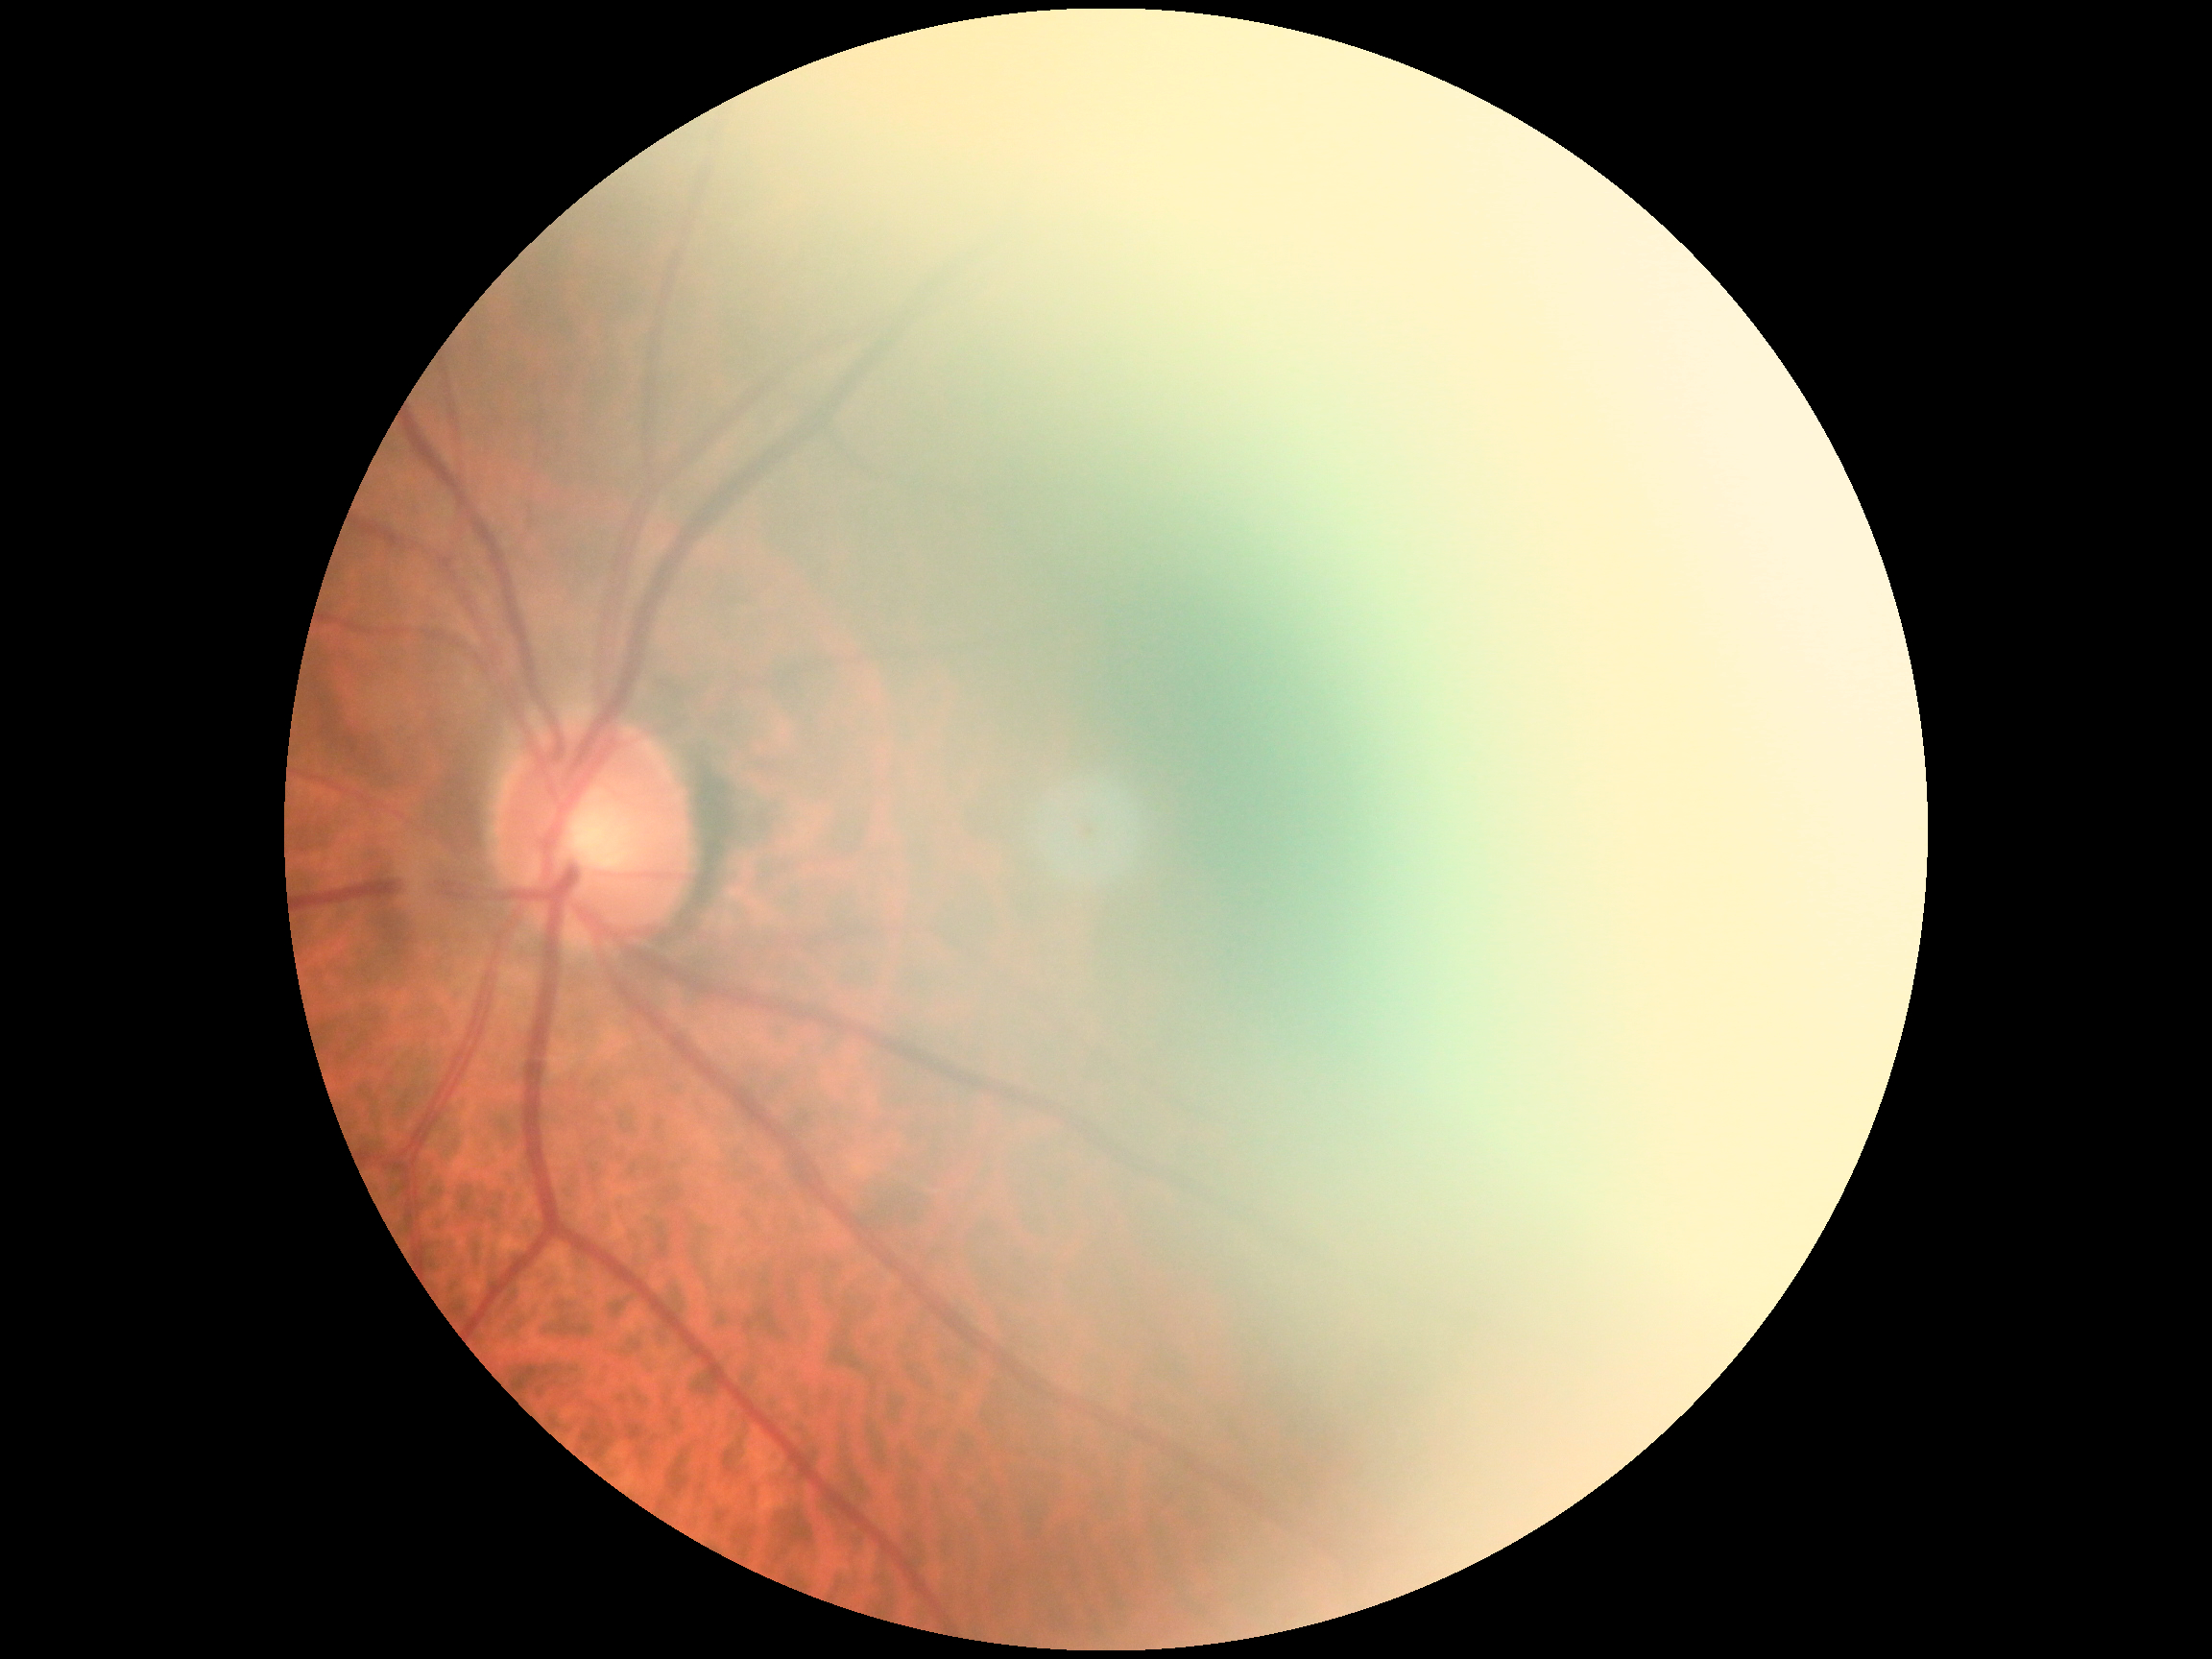

image quality: insufficient for DR assessment, diabetic retinopathy (DR): ungradable due to poor image quality.